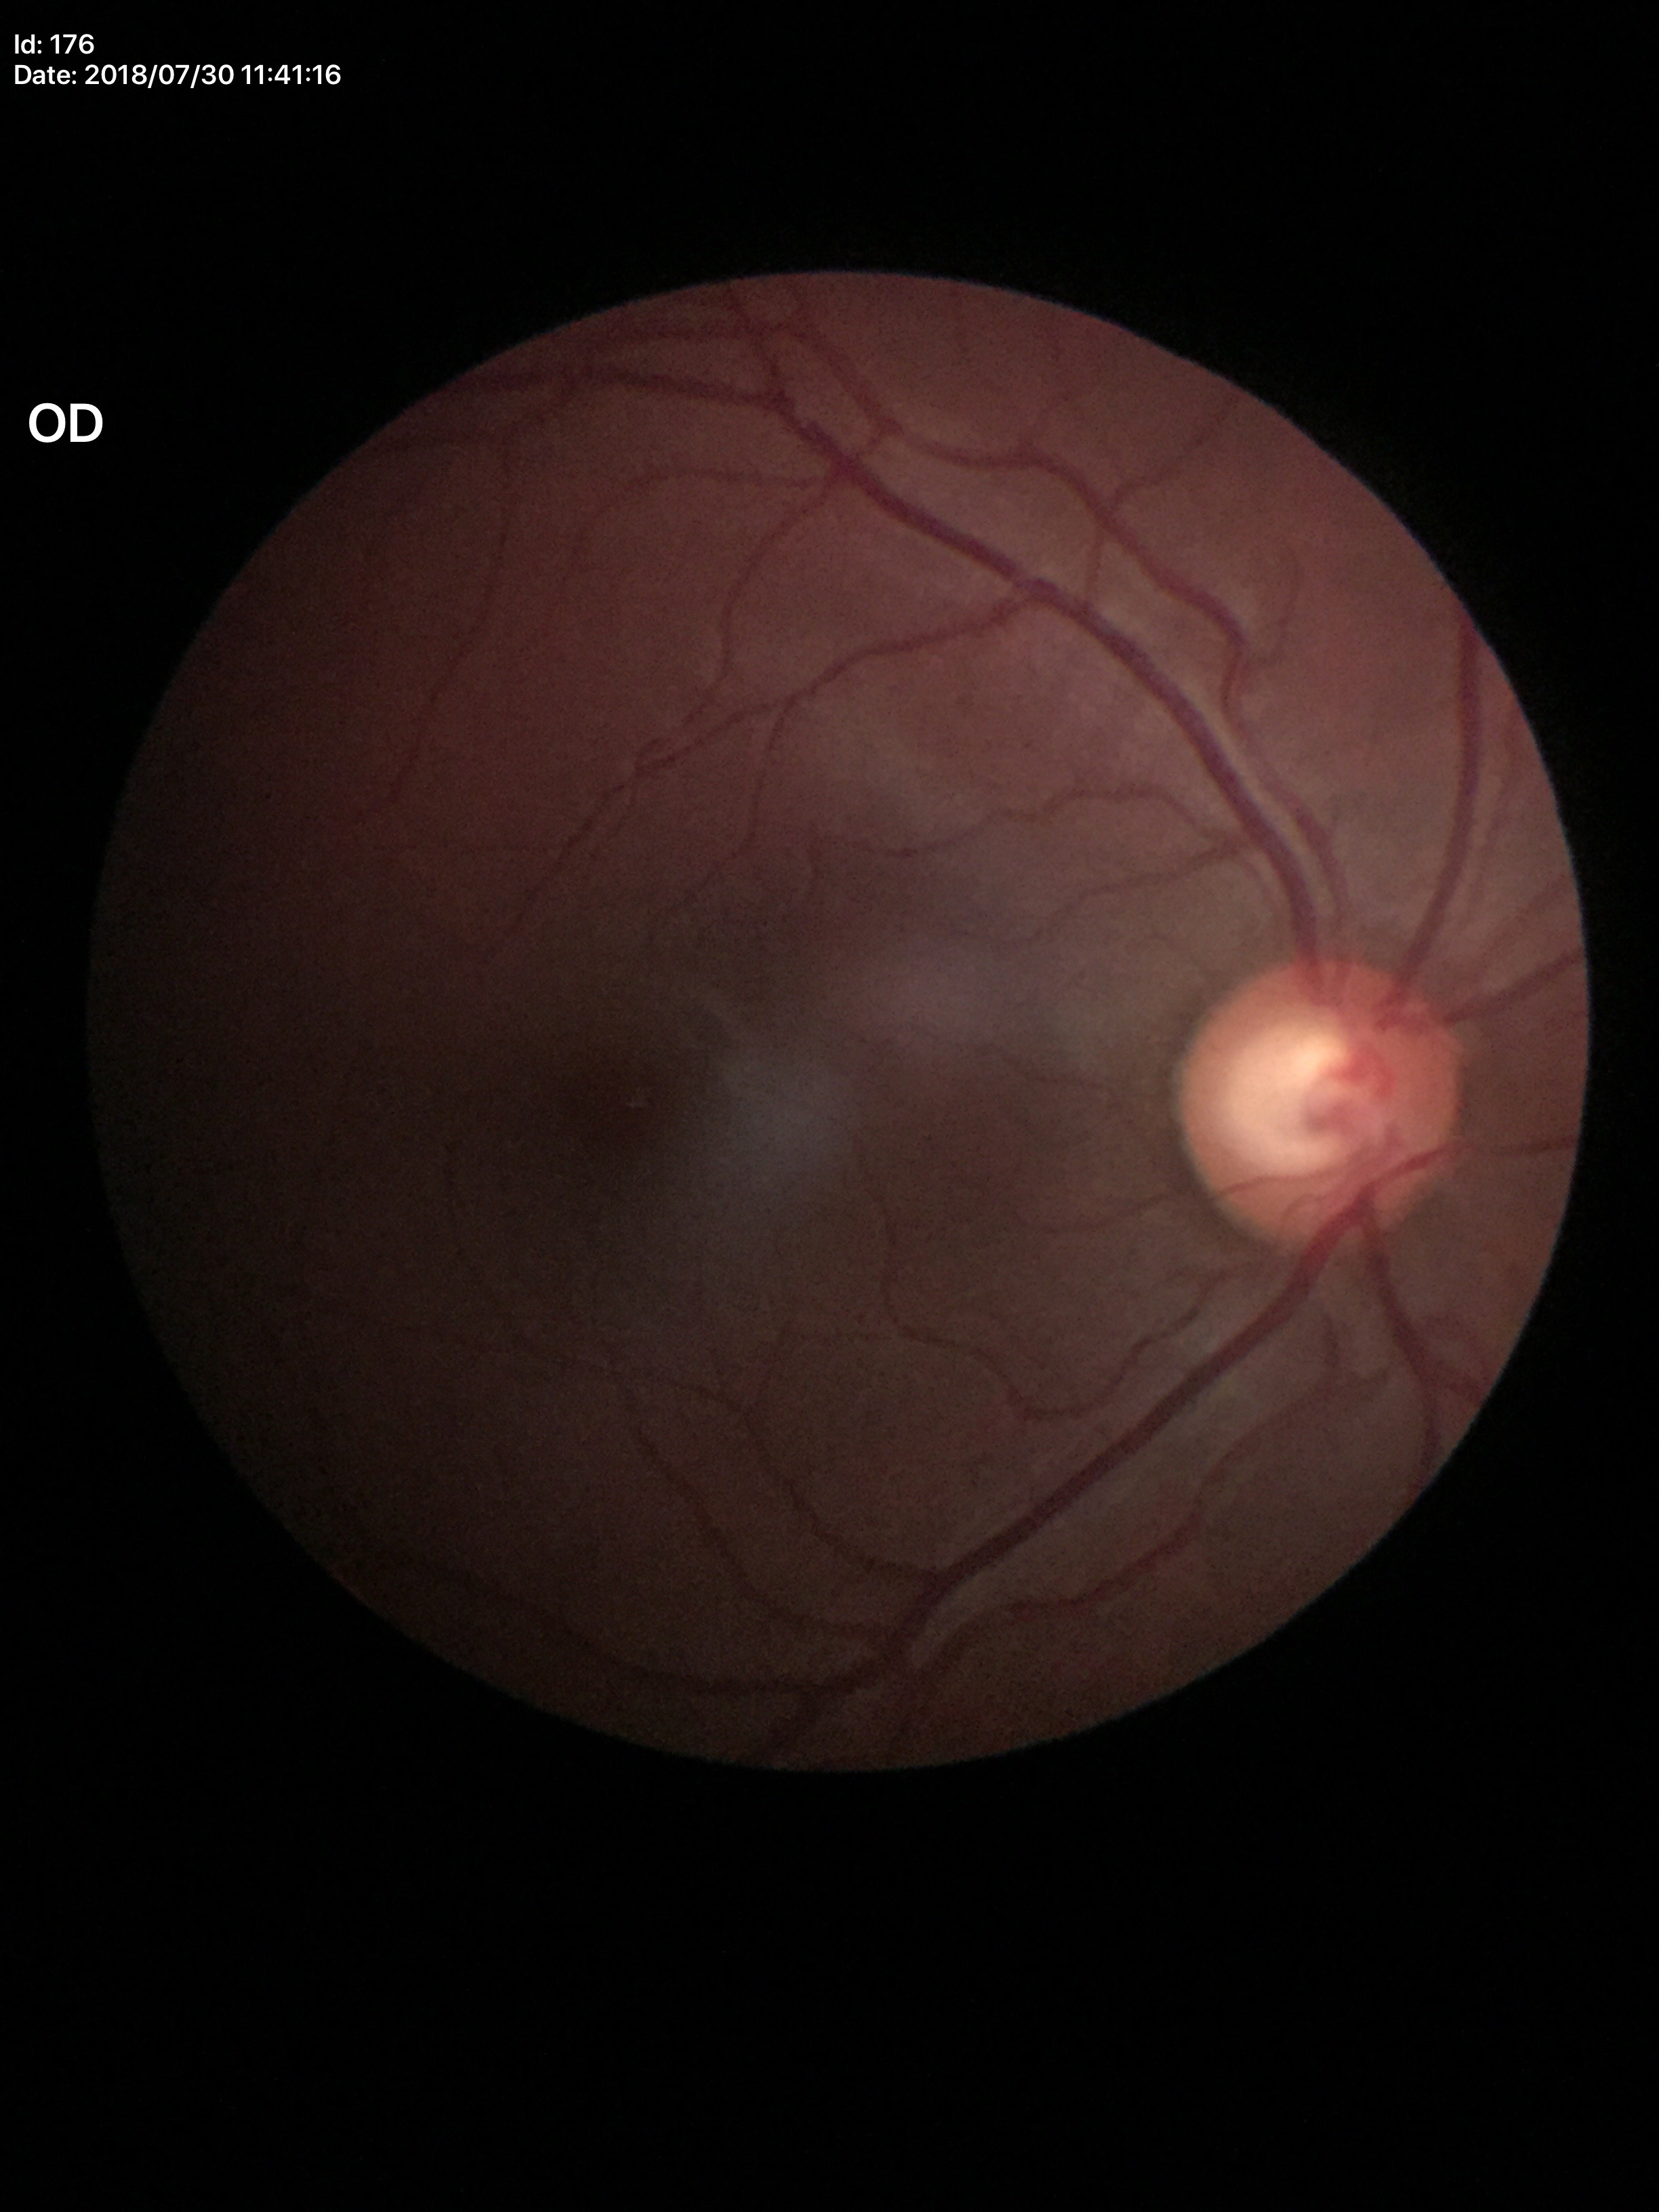

Glaucoma screening: suspicious. Vertical CDR (VCDR) is 0.63.